Wide-field fundus image from infant ROP screening; Clarity RetCam 3, 130° FOV
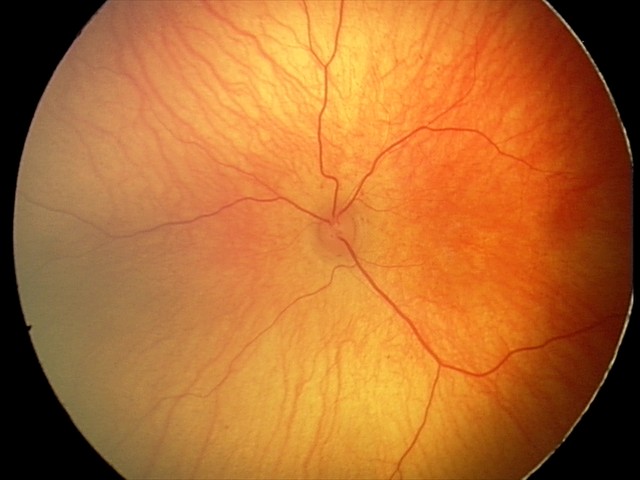 Diagnosis = normal